45° FOV.
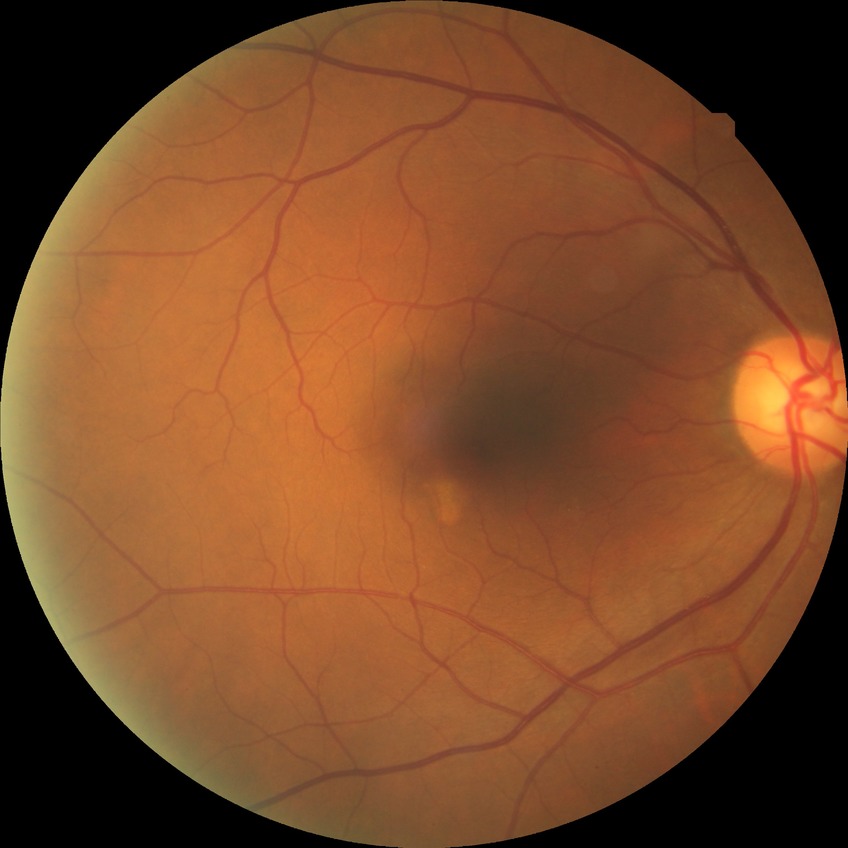

{"davis_grade": "NDR"}